Nidek AFC-330, retinal fundus photograph
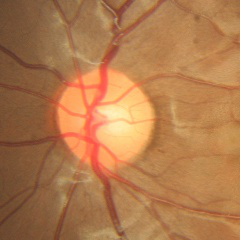 Q: Glaucoma assessment?
A: No — no signs of glaucoma.